Wide-field fundus photograph from neonatal ROP screening: 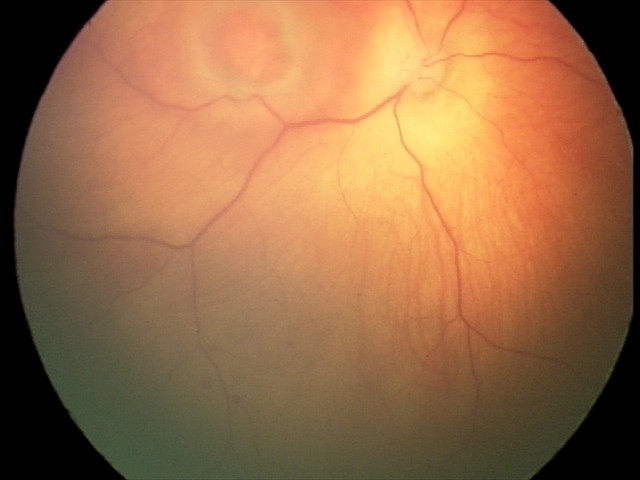
From an examination with diagnosis of toxoplasmosis chorioretinitis.